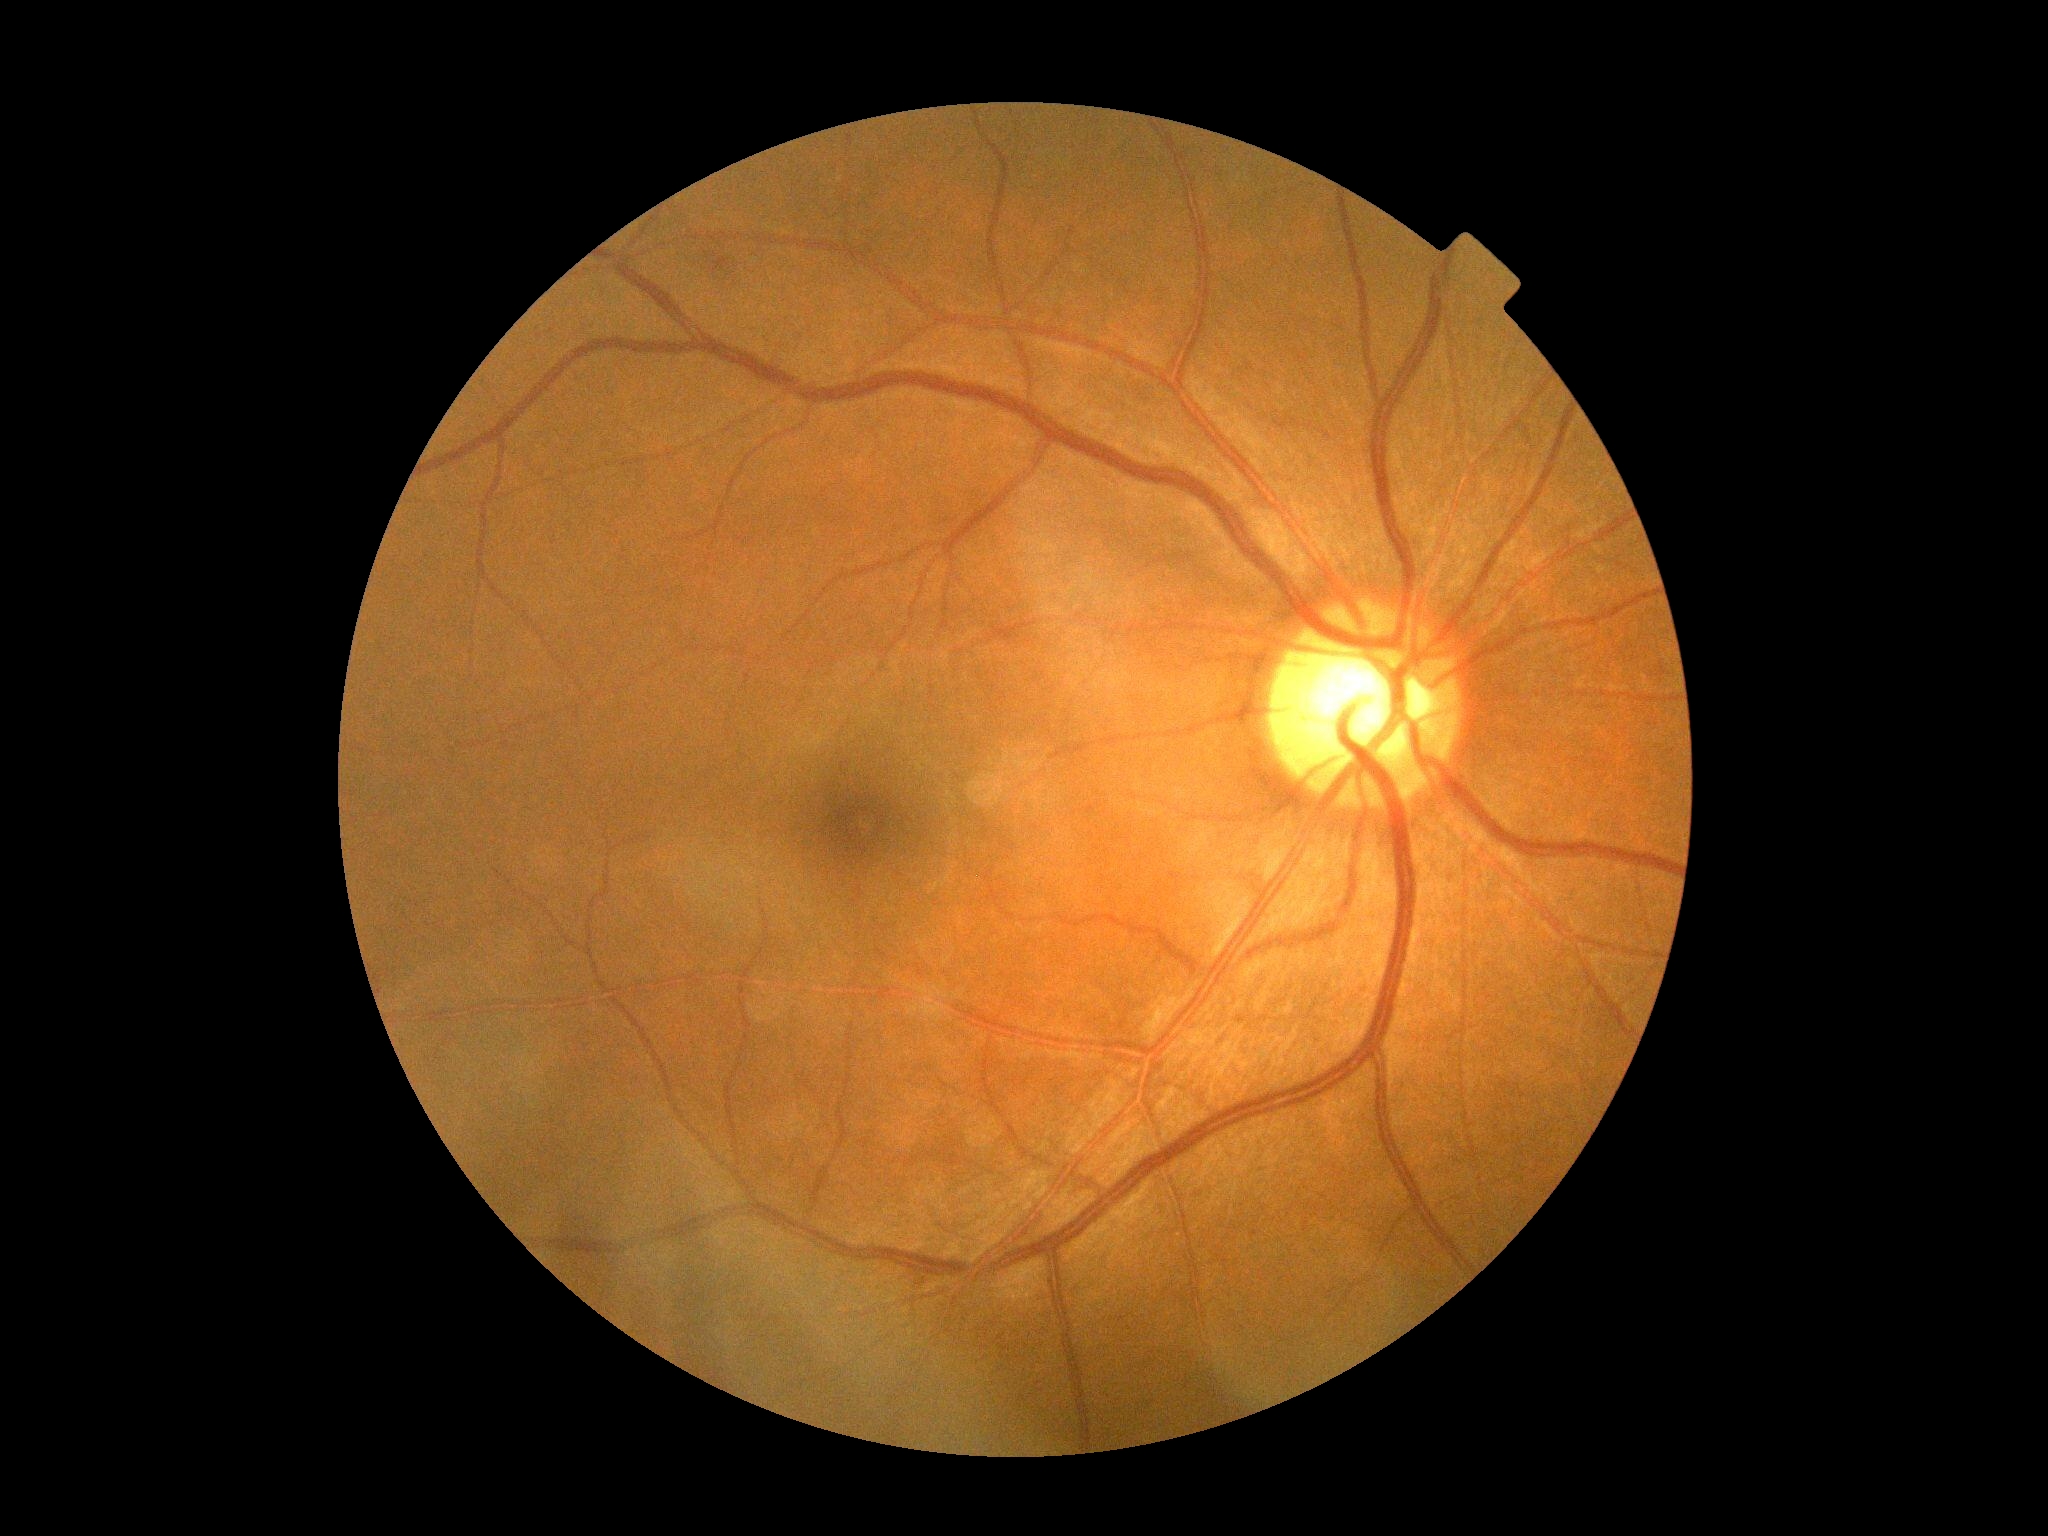

• diabetic retinopathy (DR) — grade 0 — no visible signs of diabetic retinopathy
• DR impression — no apparent DR